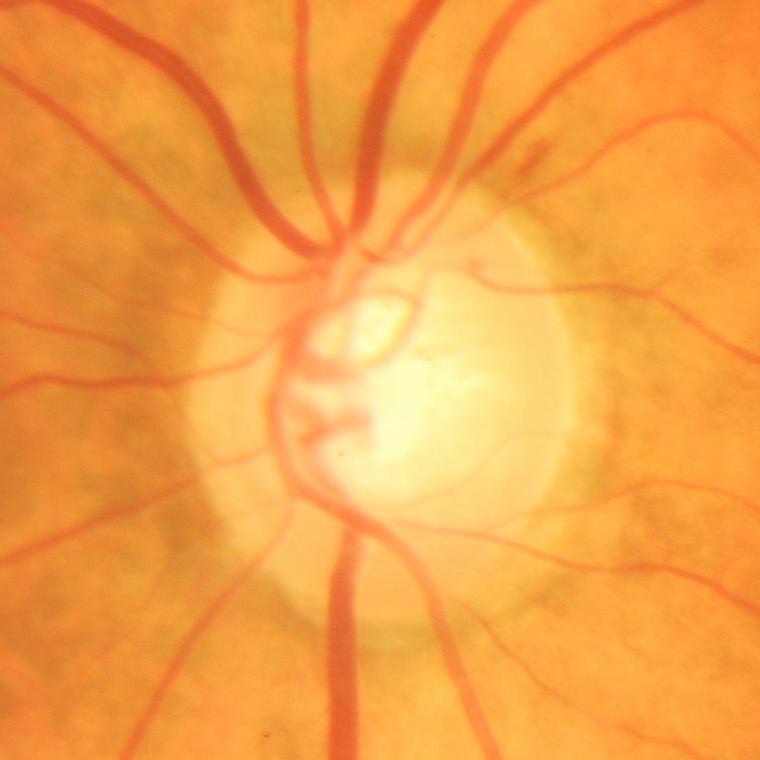

Q: Does this eye have glaucoma?
A: Yes — evidence of glaucoma.